Pediatric wide-field fundus photograph
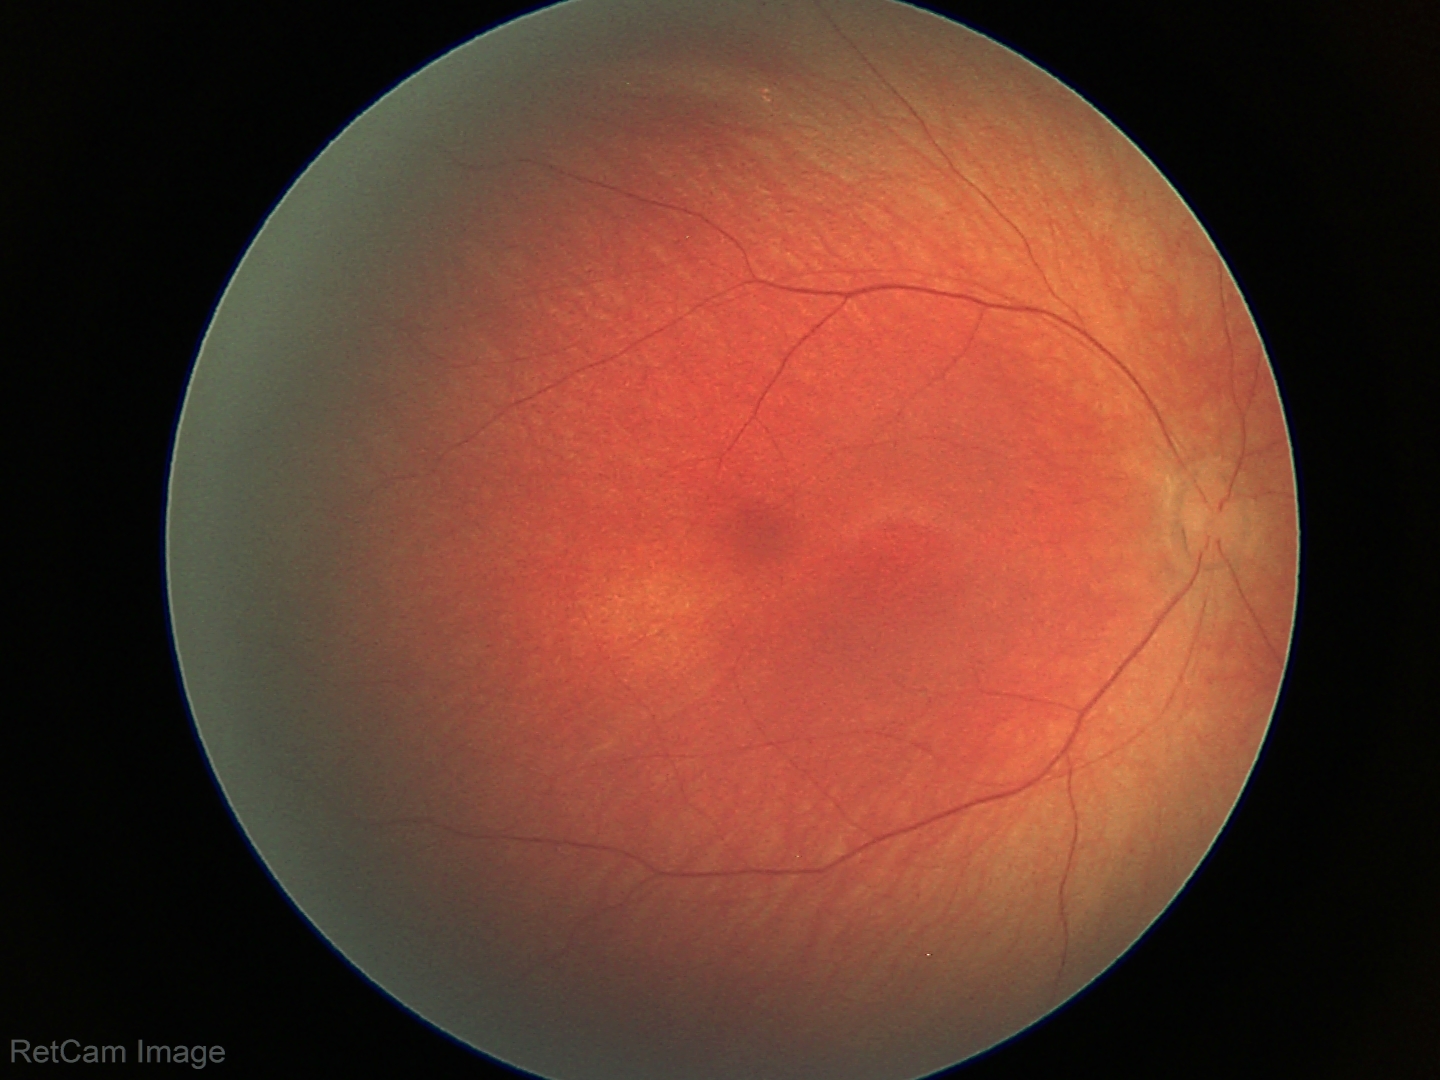

Q: What is the diagnosis from this examination?
A: physiological finding